35° FOV before cropping; optic nerve head photograph: 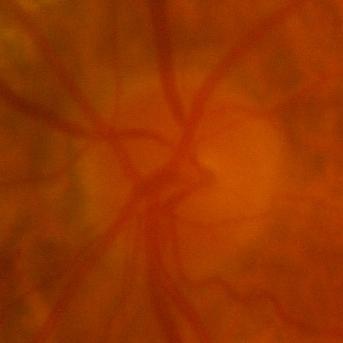

Glaucoma status = no signs of glaucoma.